CFP. 2228x1652 — 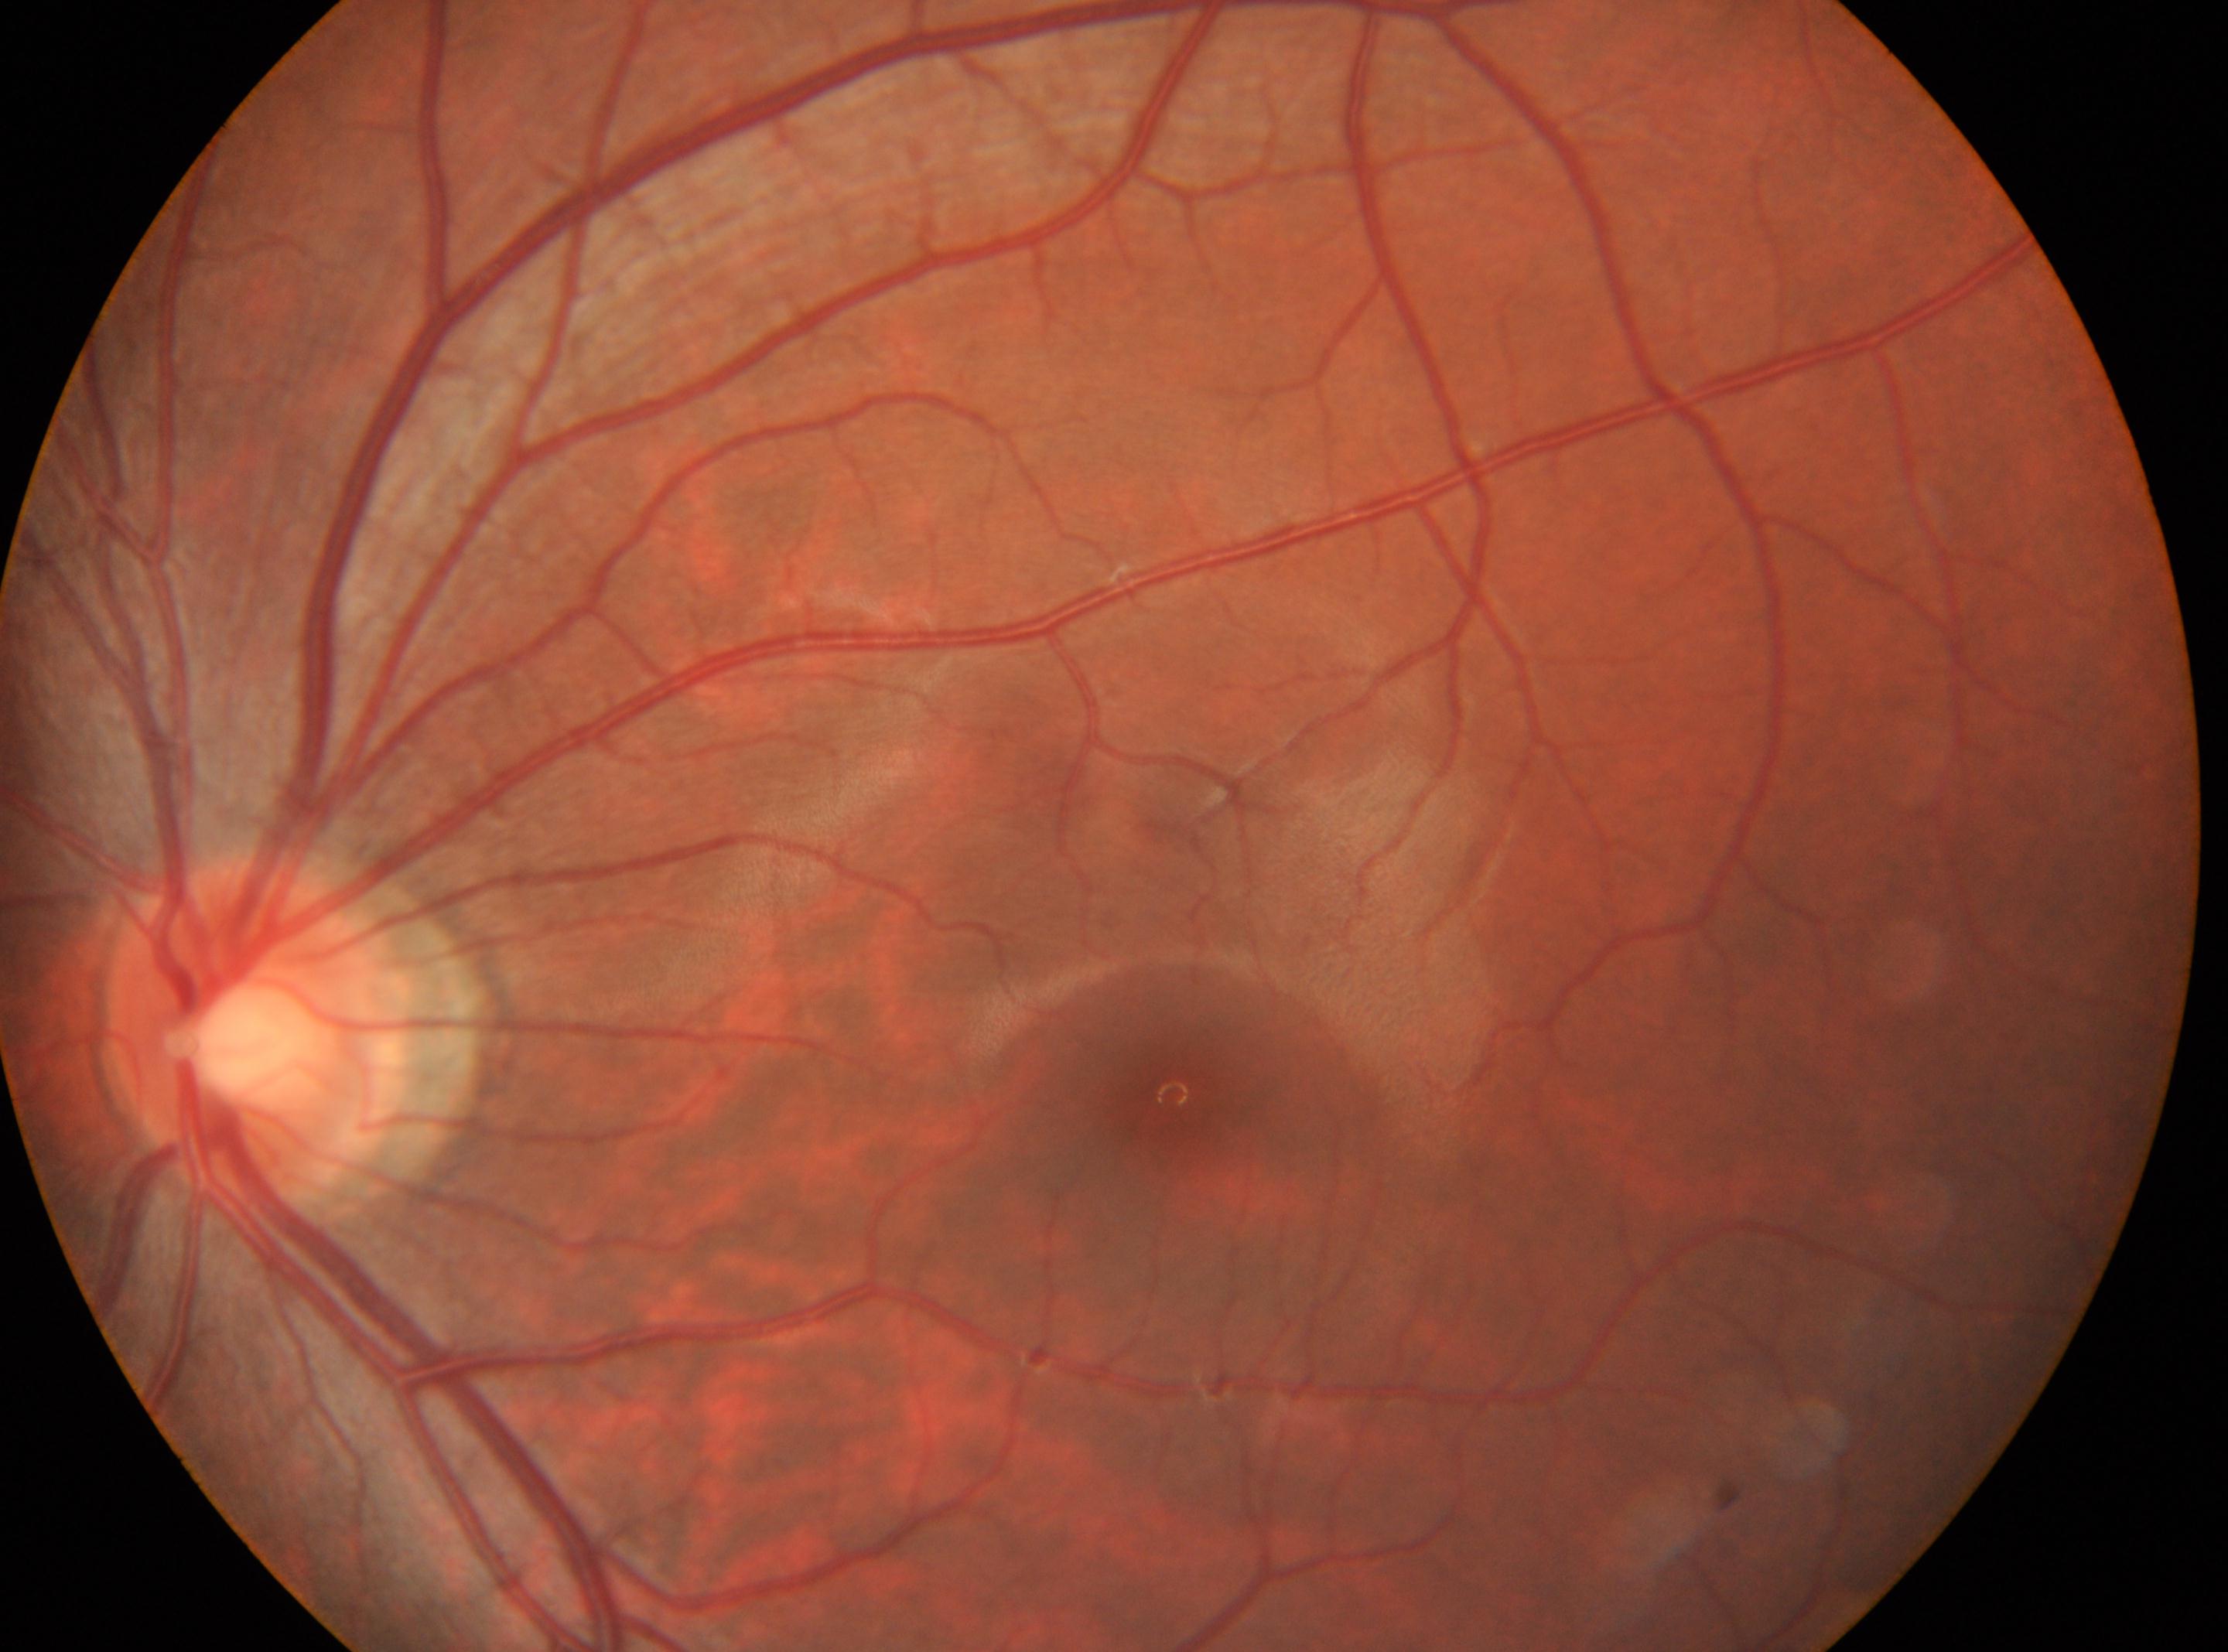

Findings:
* optic disc center: 255, 1028
* diabetic retinopathy (DR): no apparent retinopathy (grade 0)
* laterality: oculus sinister
* fovea: 1171, 1094